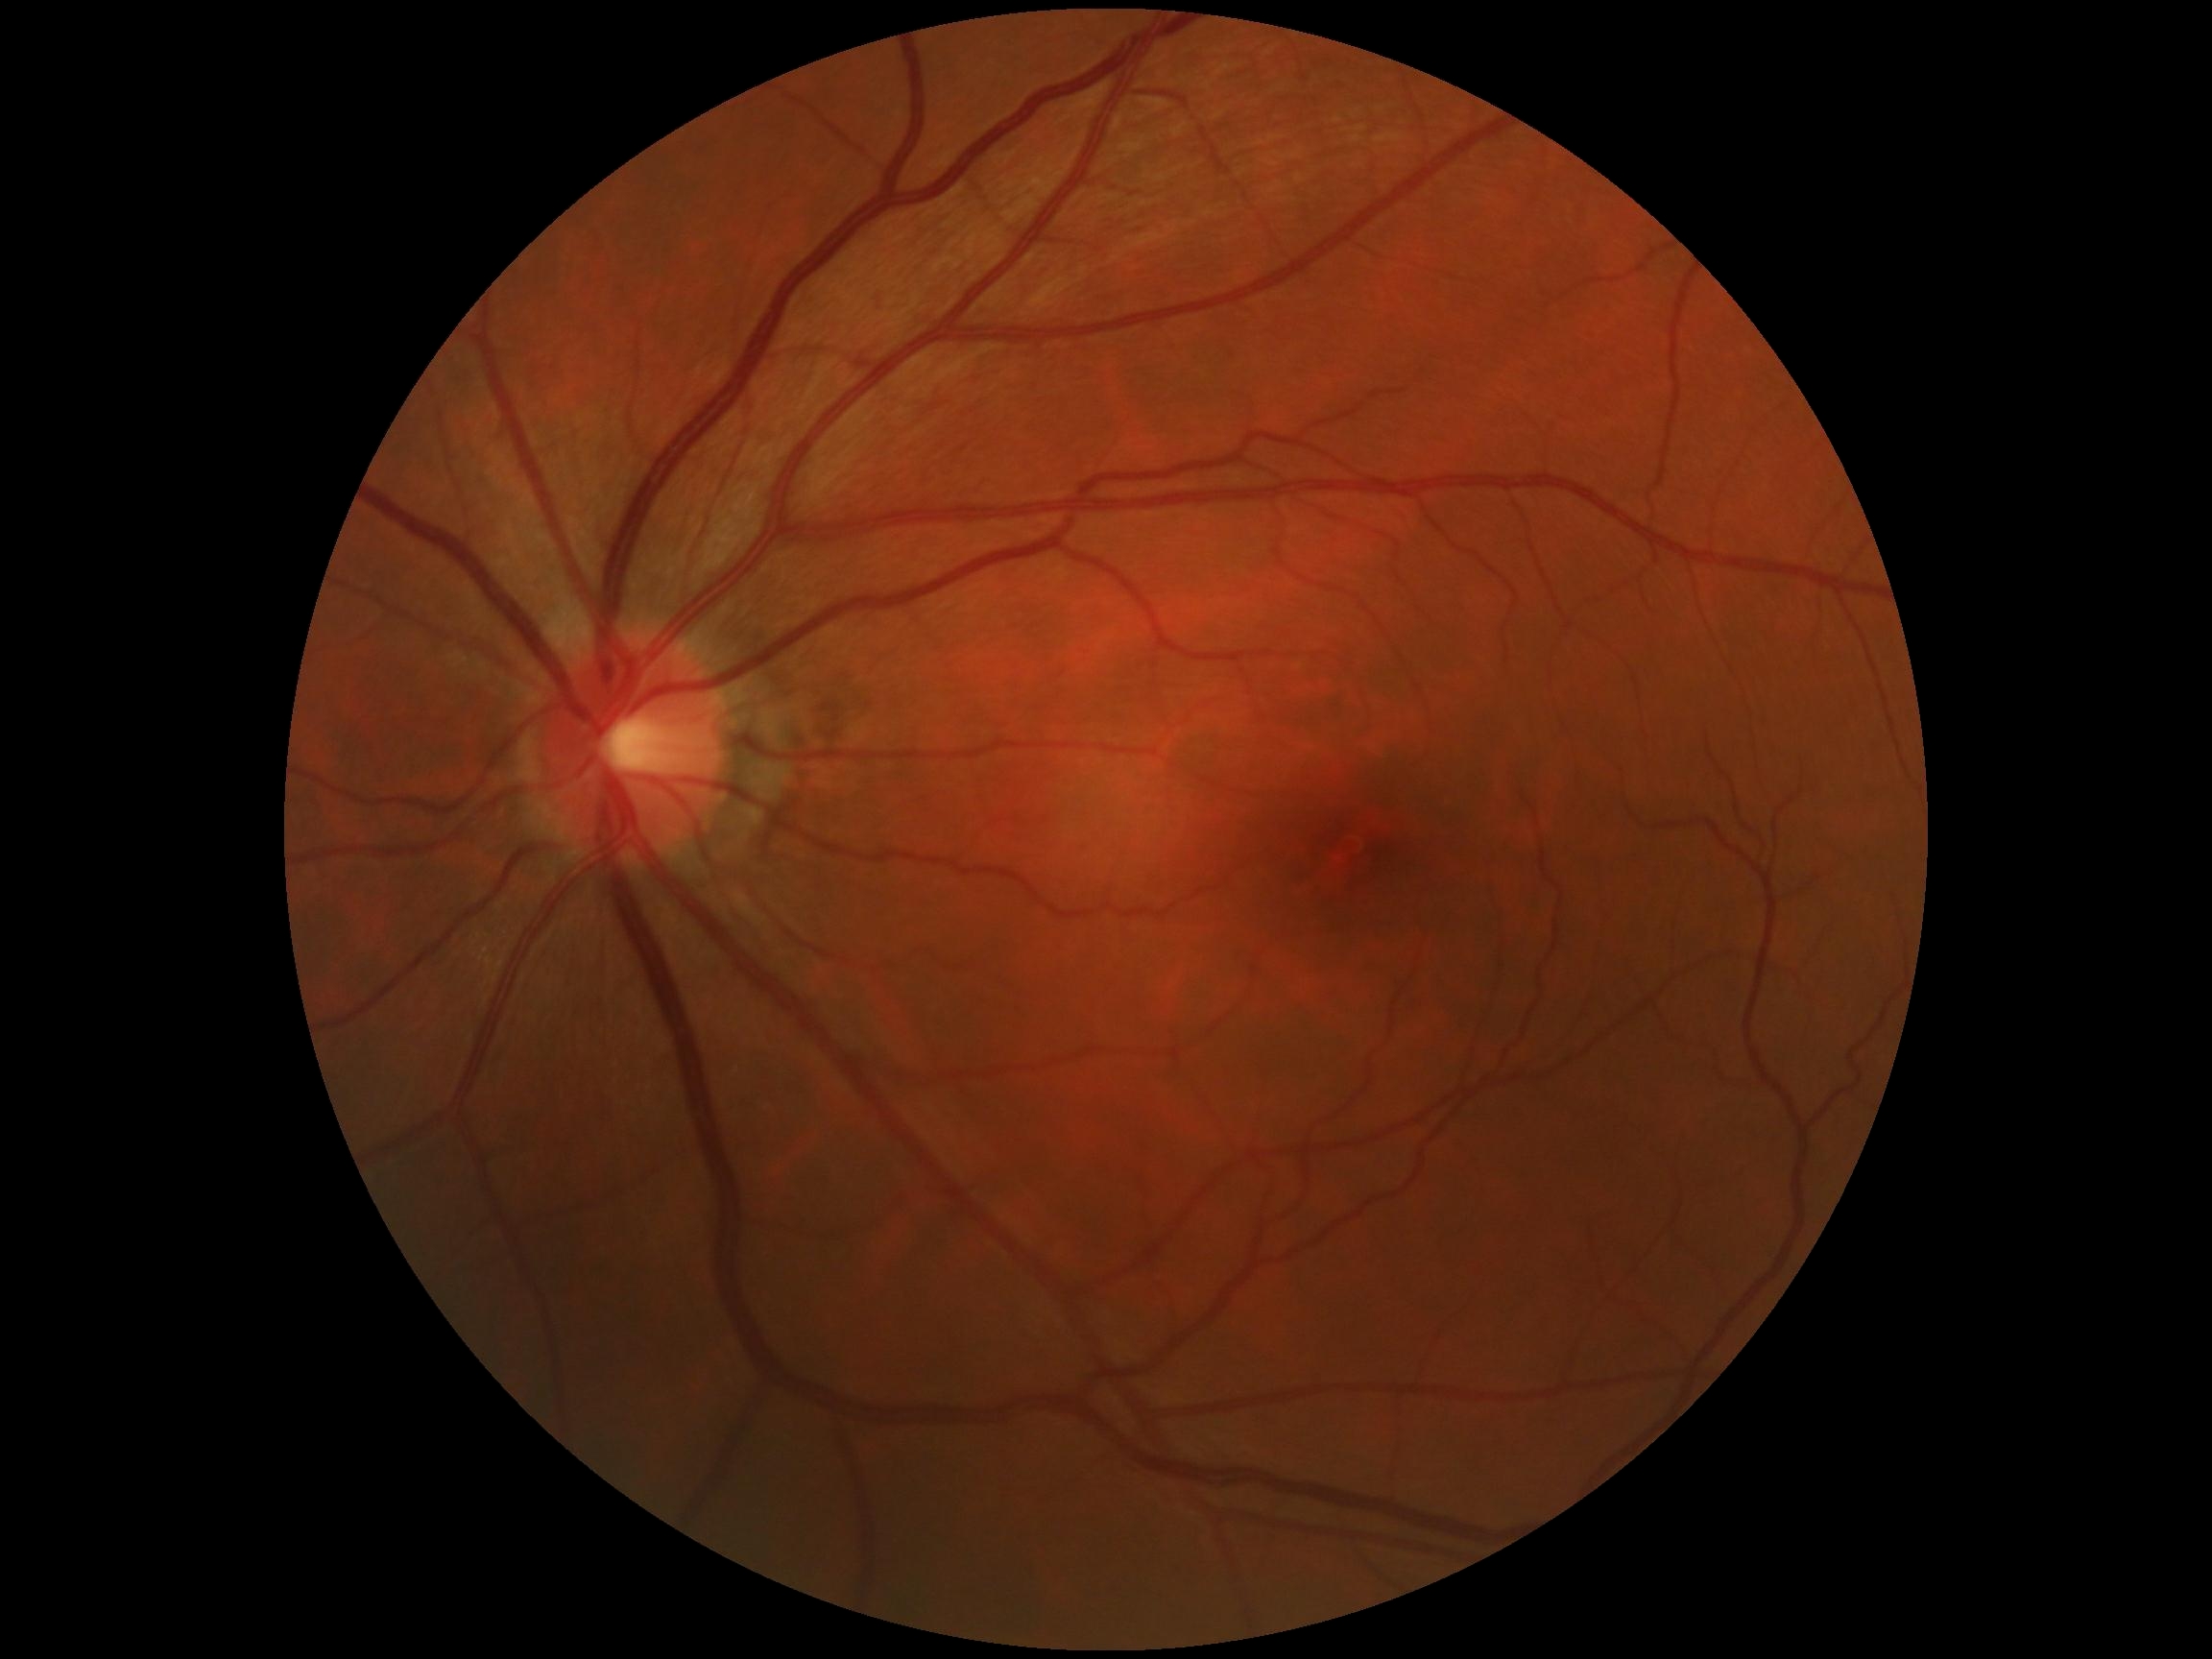 DR impression: no DR findings; diabetic retinopathy (DR): grade 0 (no apparent retinopathy).